Captured on a Remidio FOP fundus camera.
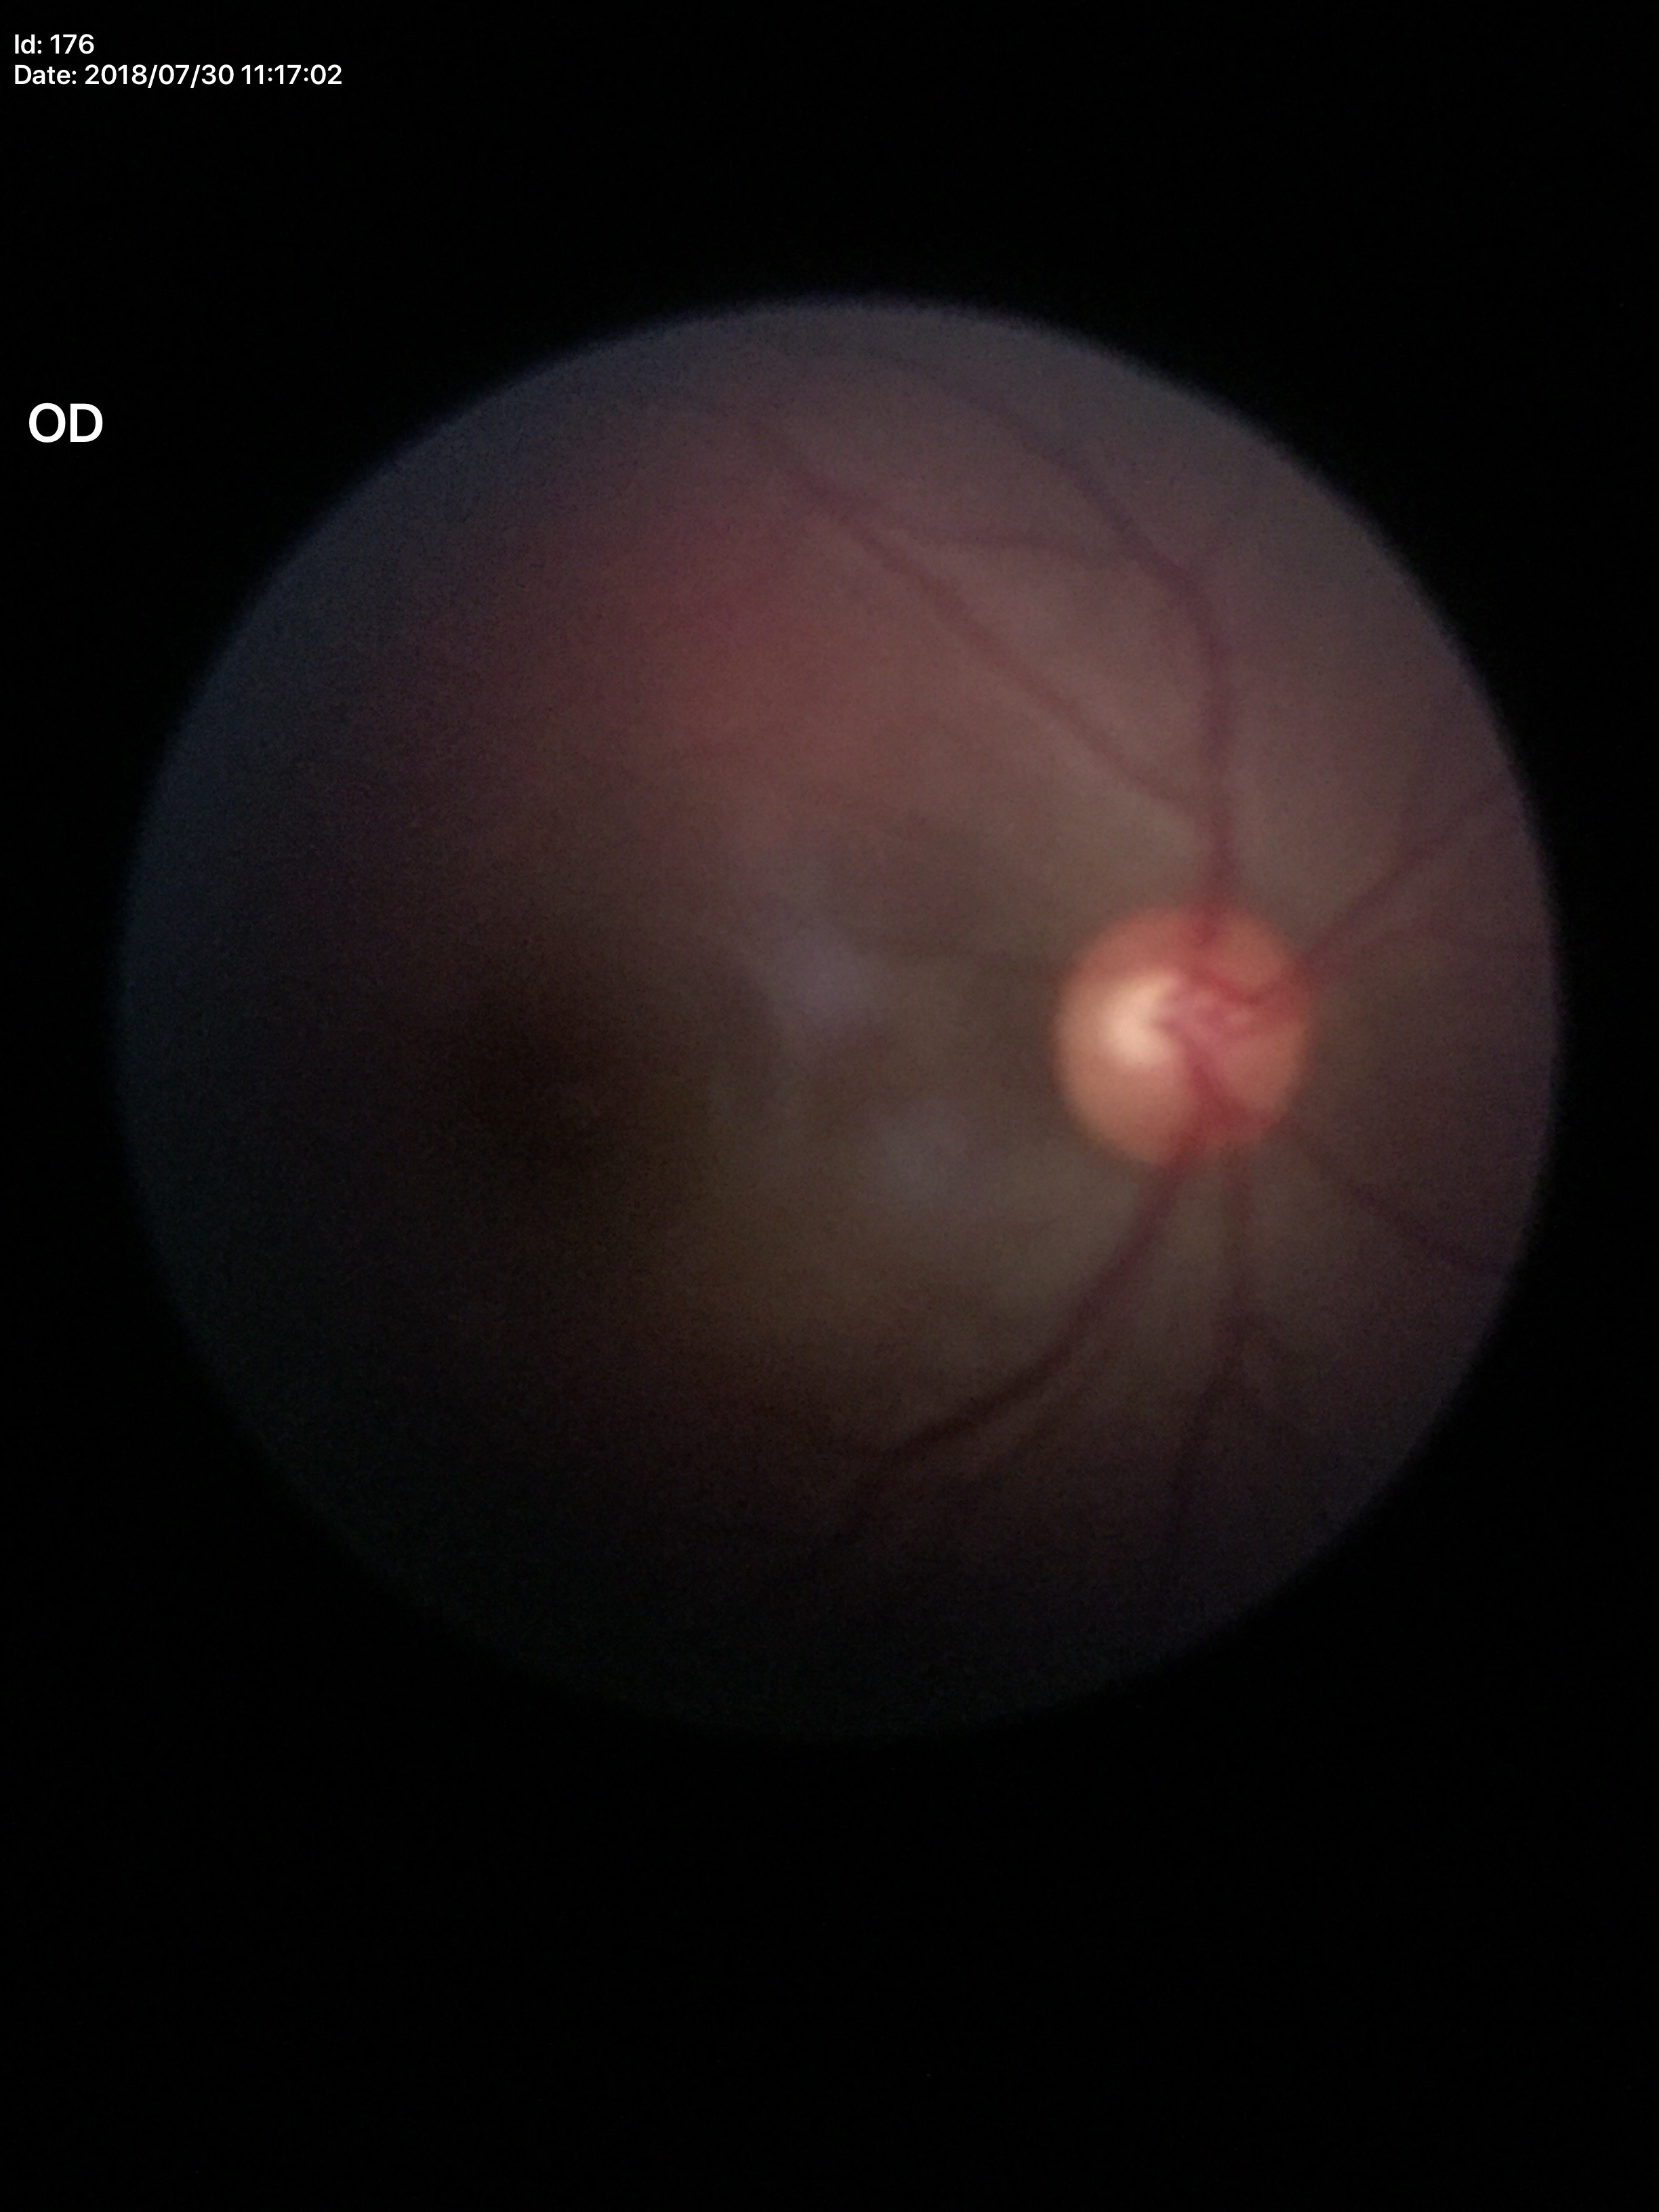
  glaucoma_decision: negative
  vcdr: 0.50